Fundus photo. 2184 by 1690 pixels. 45° field of view:
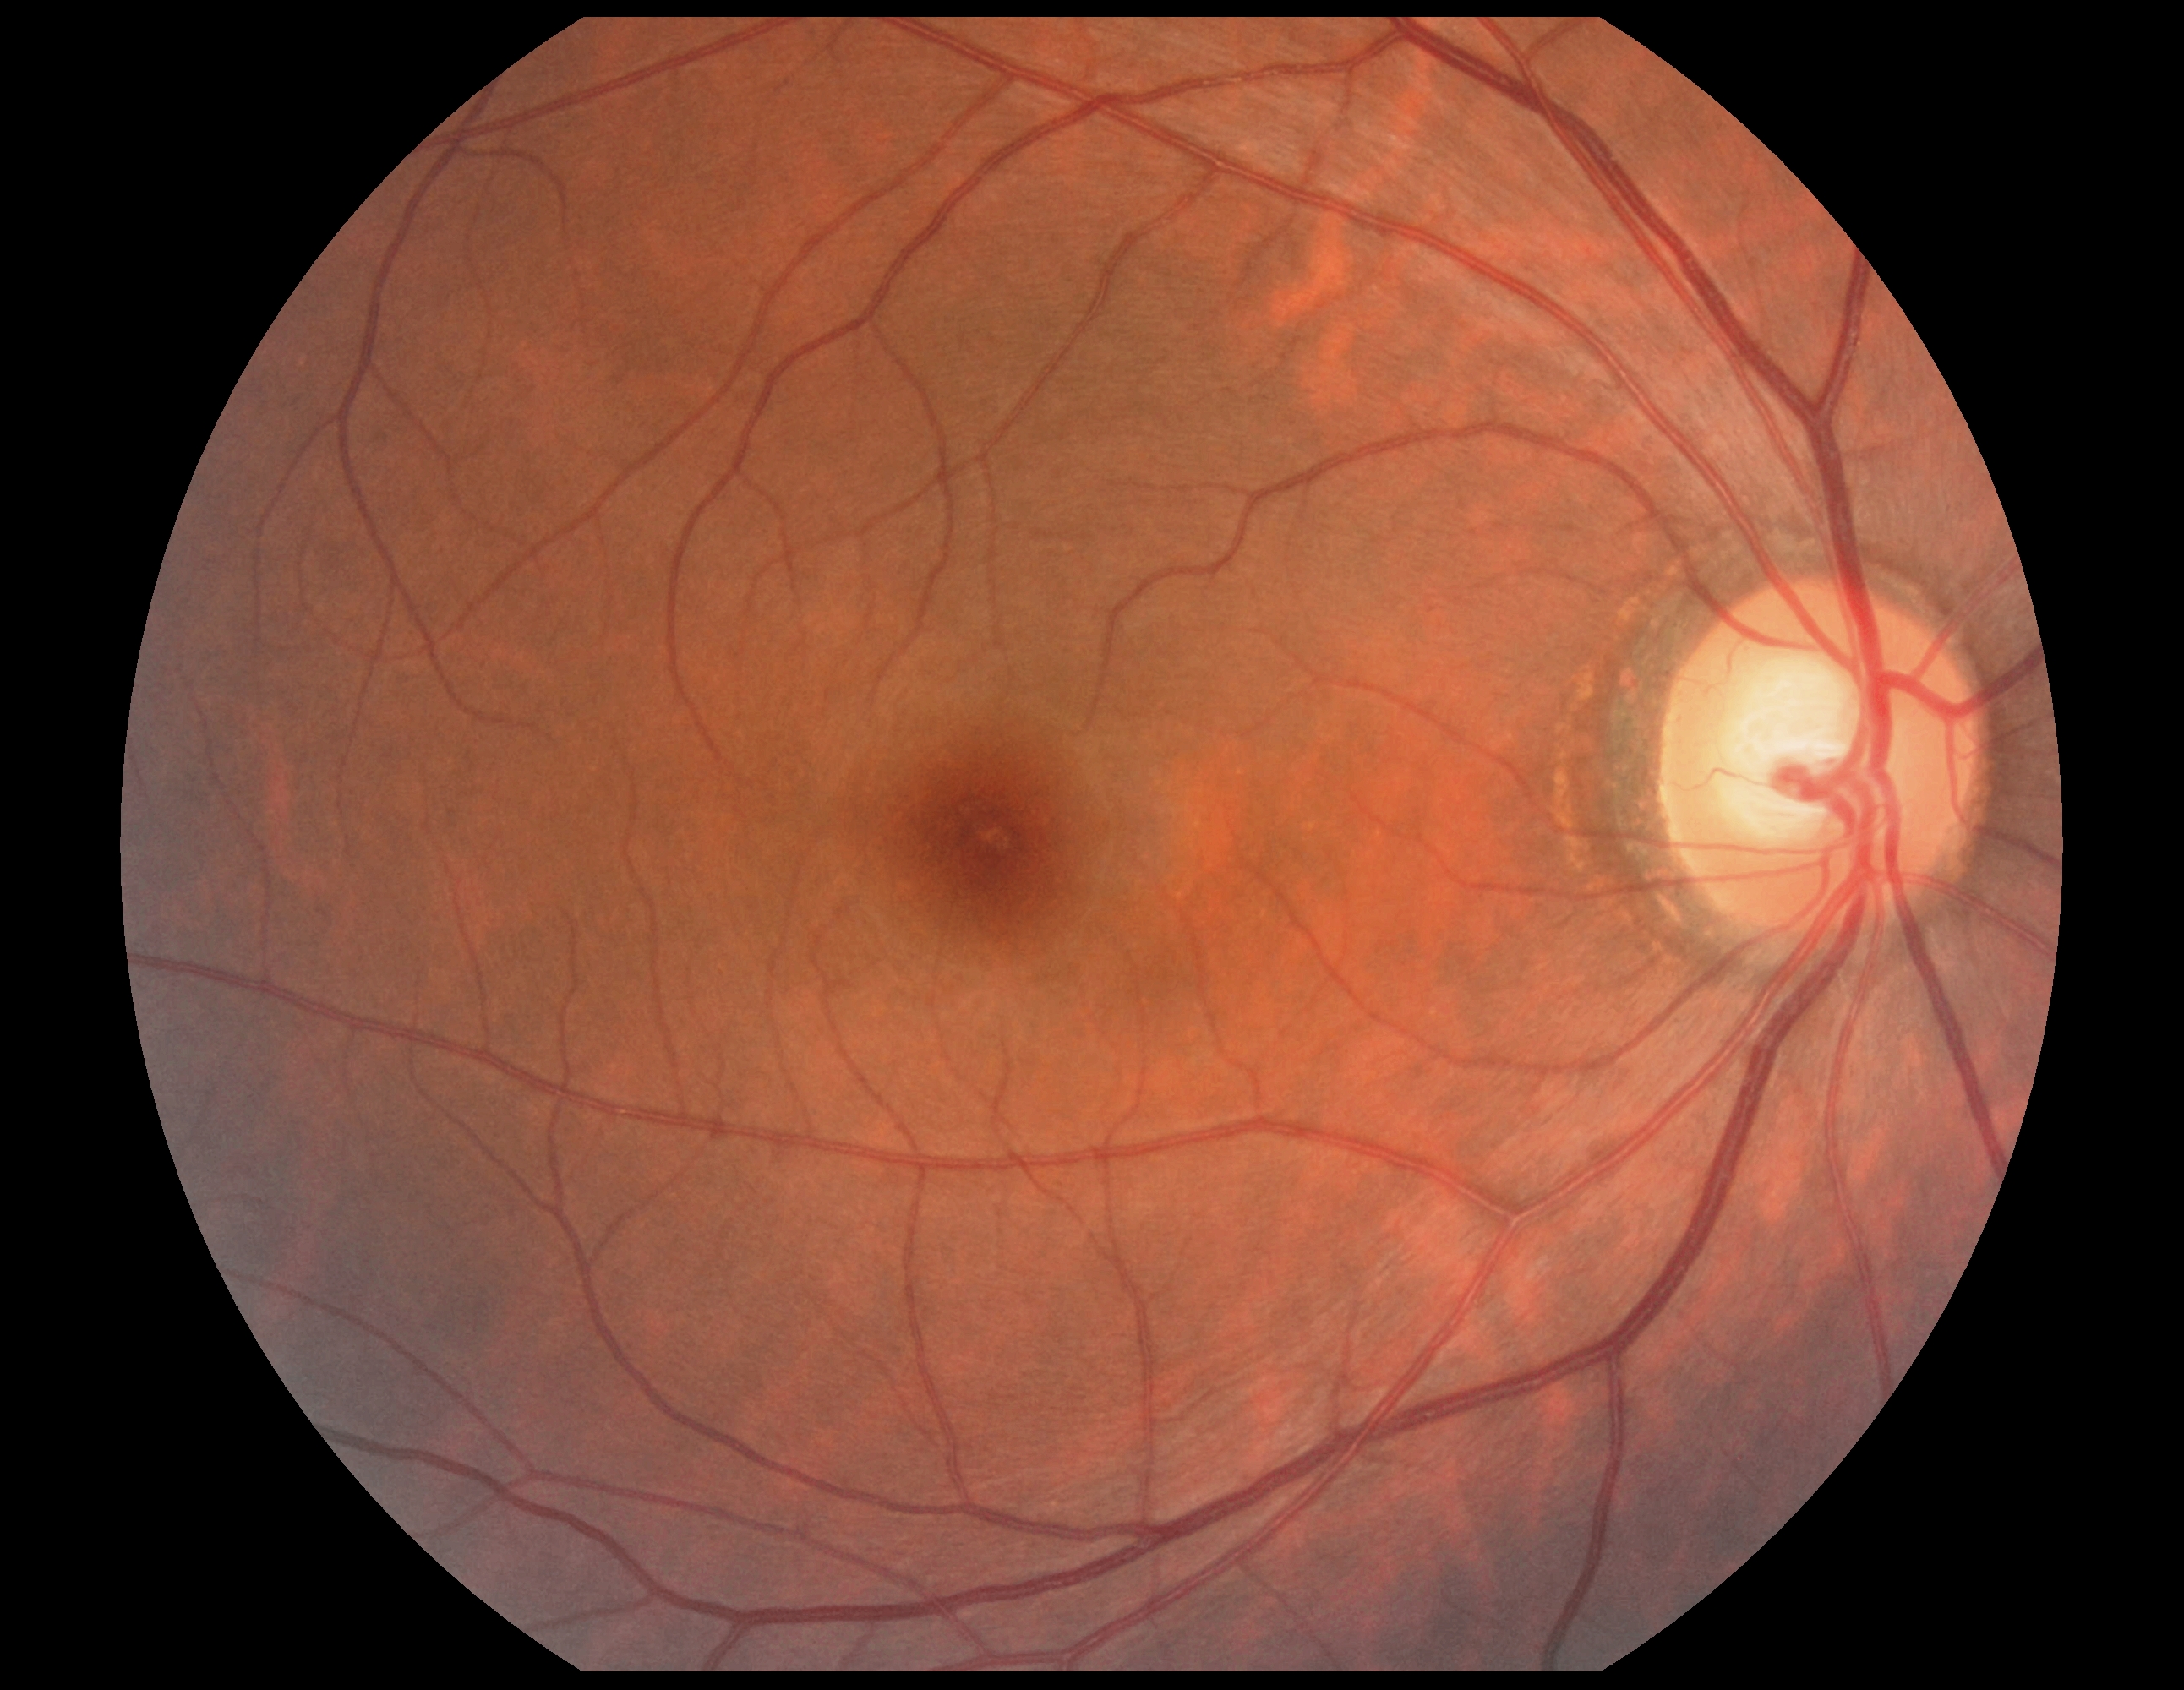

  dr_grade: grade 0
  dr_impression: no apparent DR